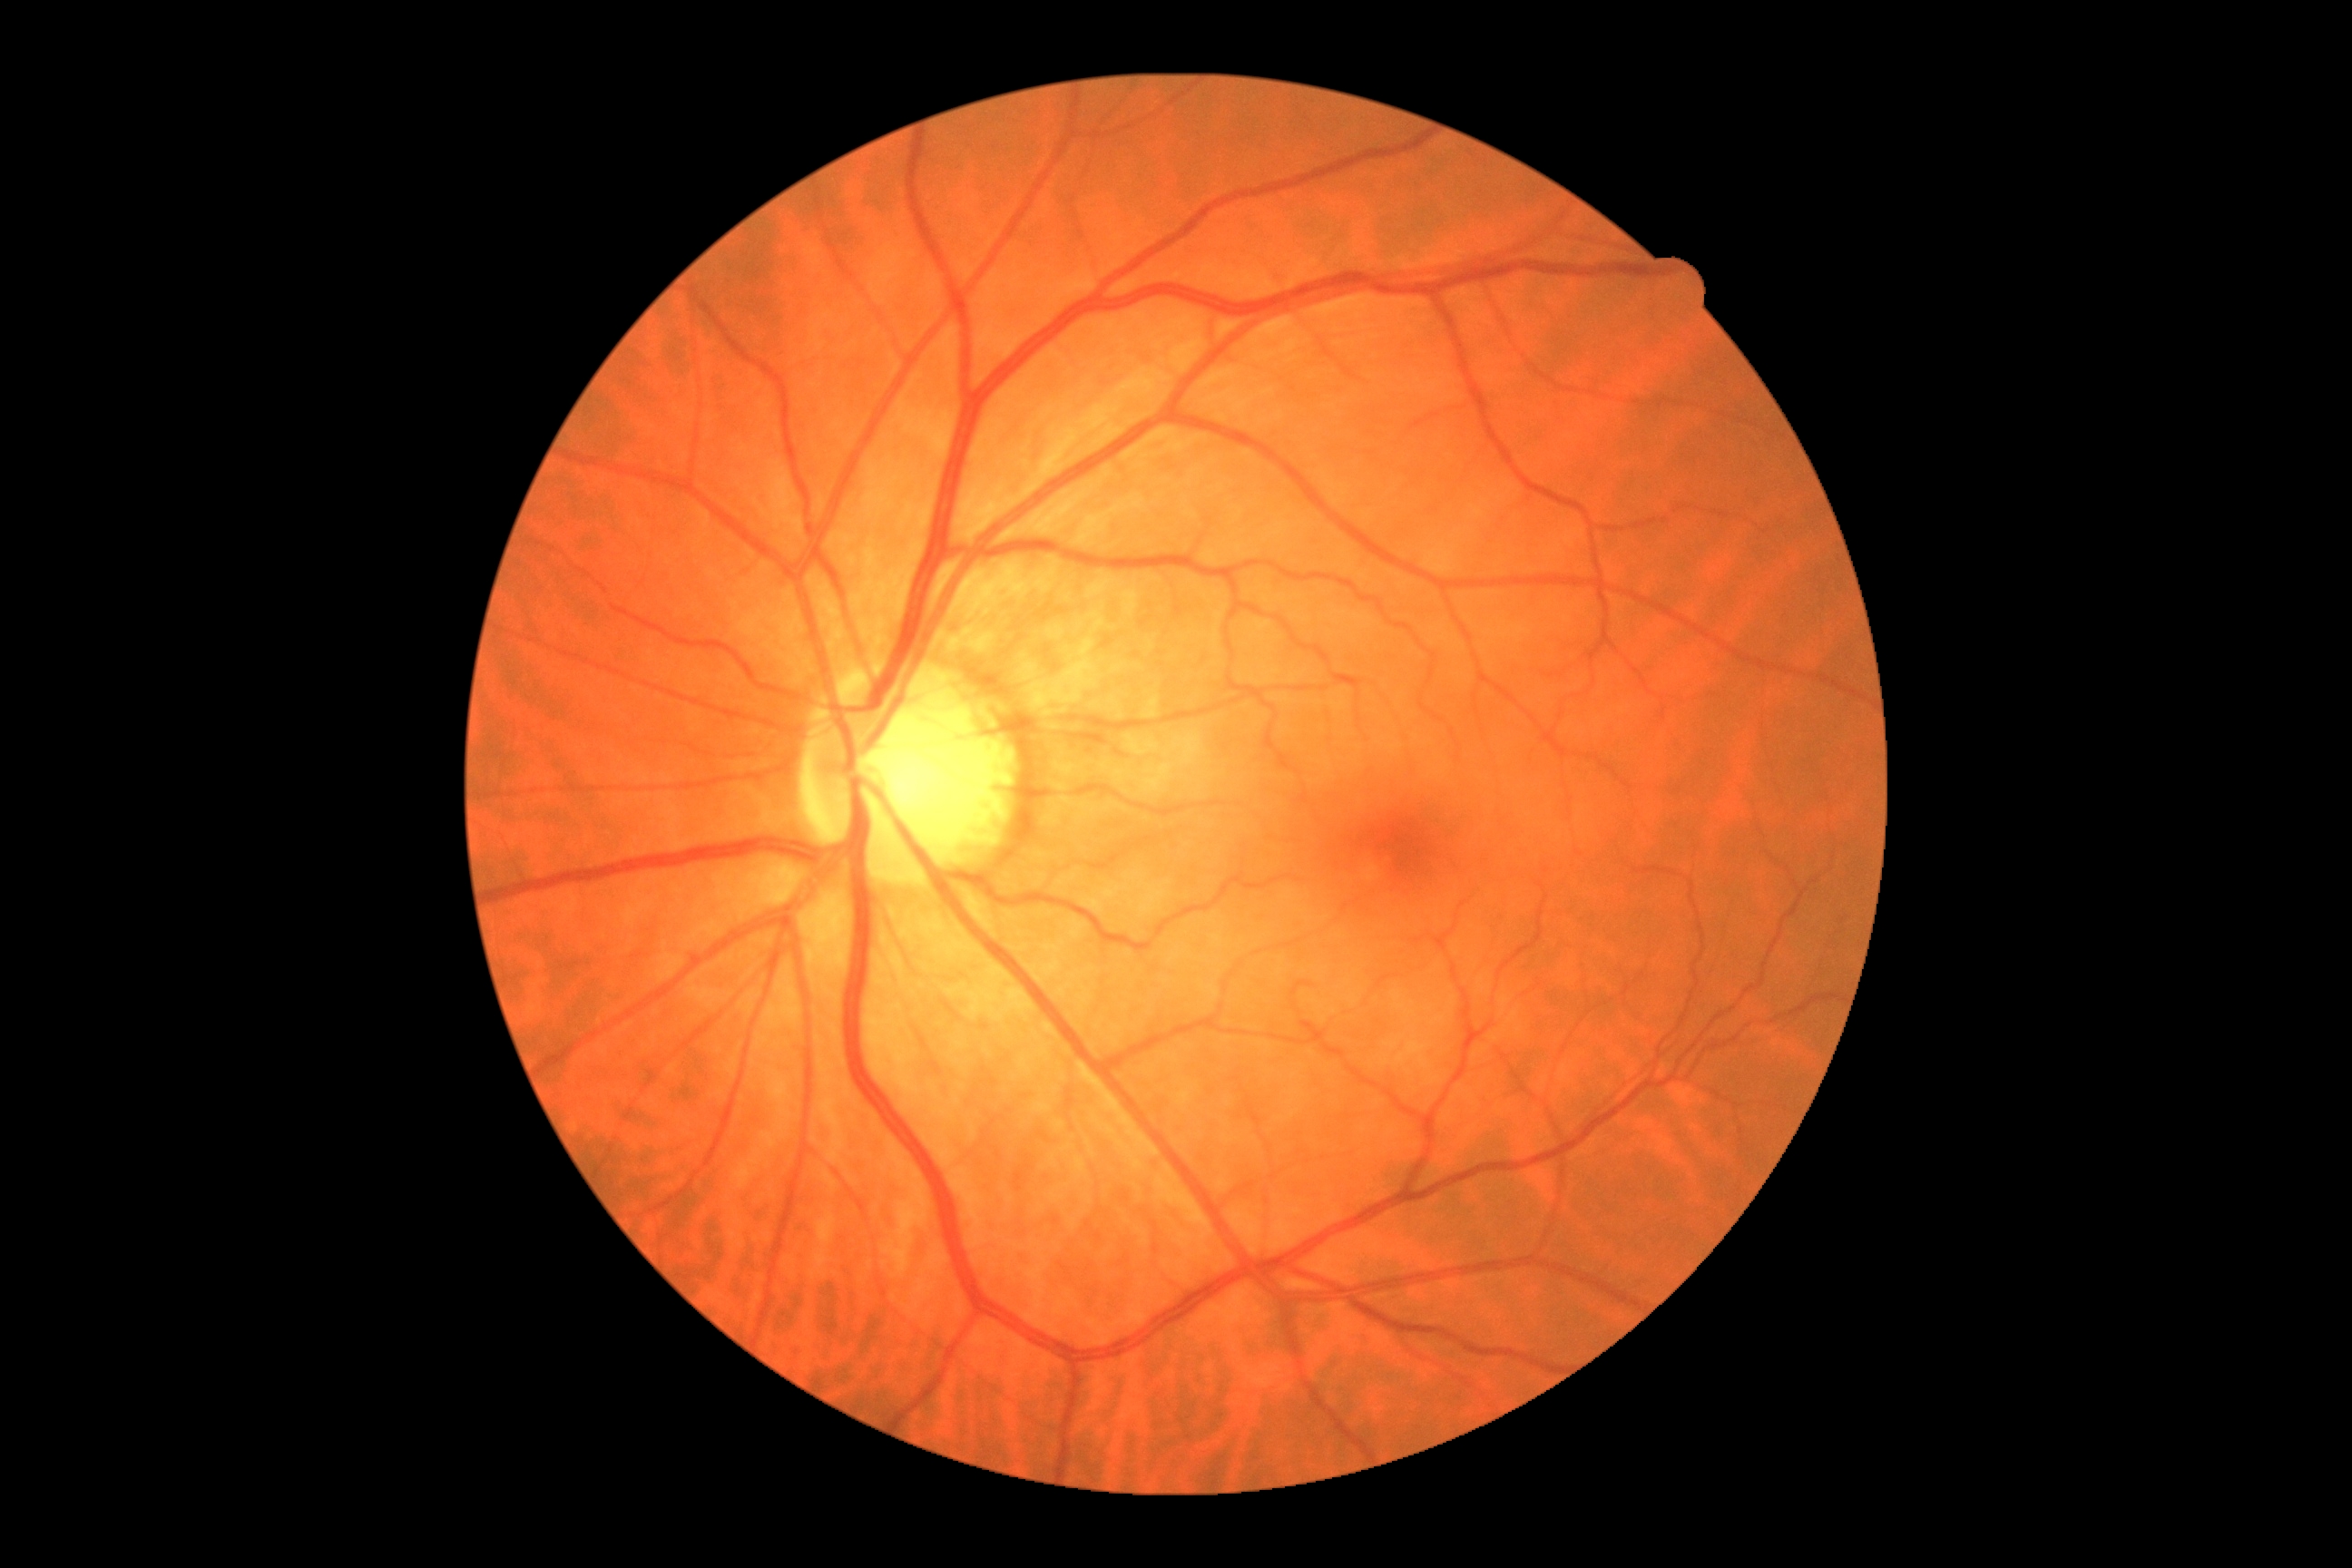
DR: no apparent retinopathy (grade 0) — no visible signs of diabetic retinopathy.